Graded on the modified Davis scale. 848 x 848 pixels. Fundus photo. 45° field of view.
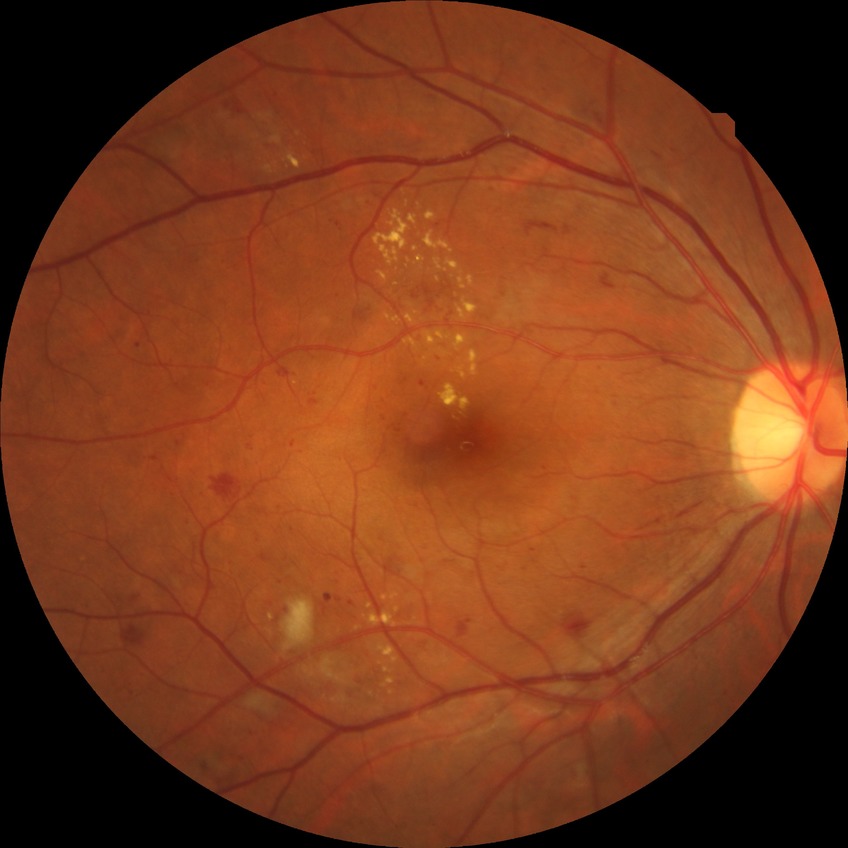

diabetic retinopathy stage: pre-proliferative diabetic retinopathy.